848 x 848 pixels — 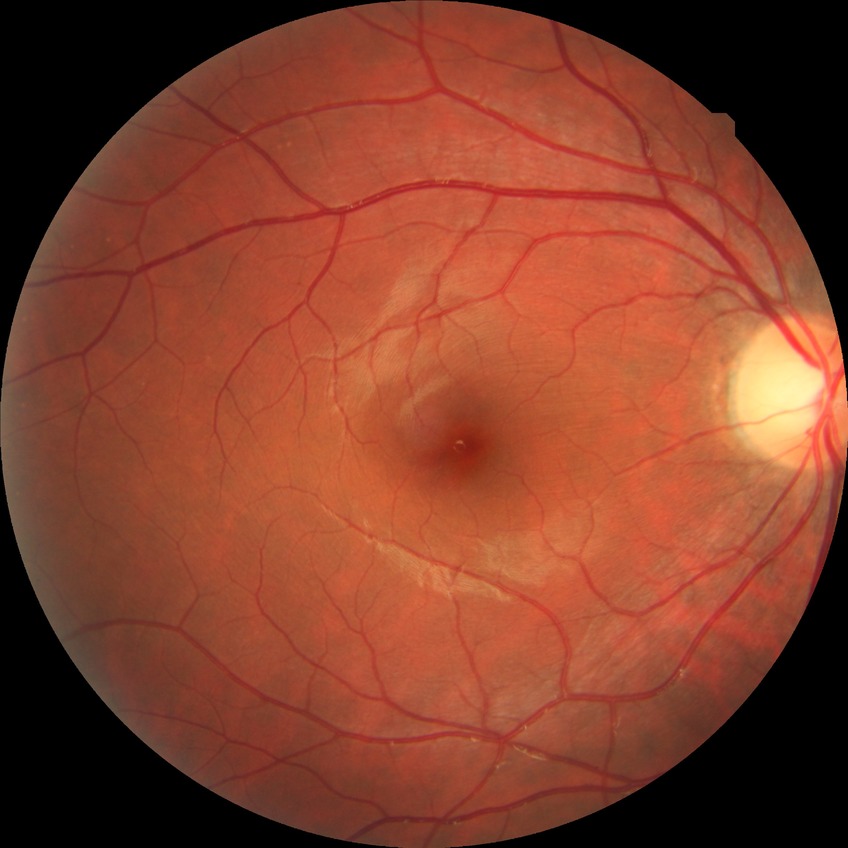 Assessment:
• diabetic retinopathy (DR): no diabetic retinopathy (NDR)